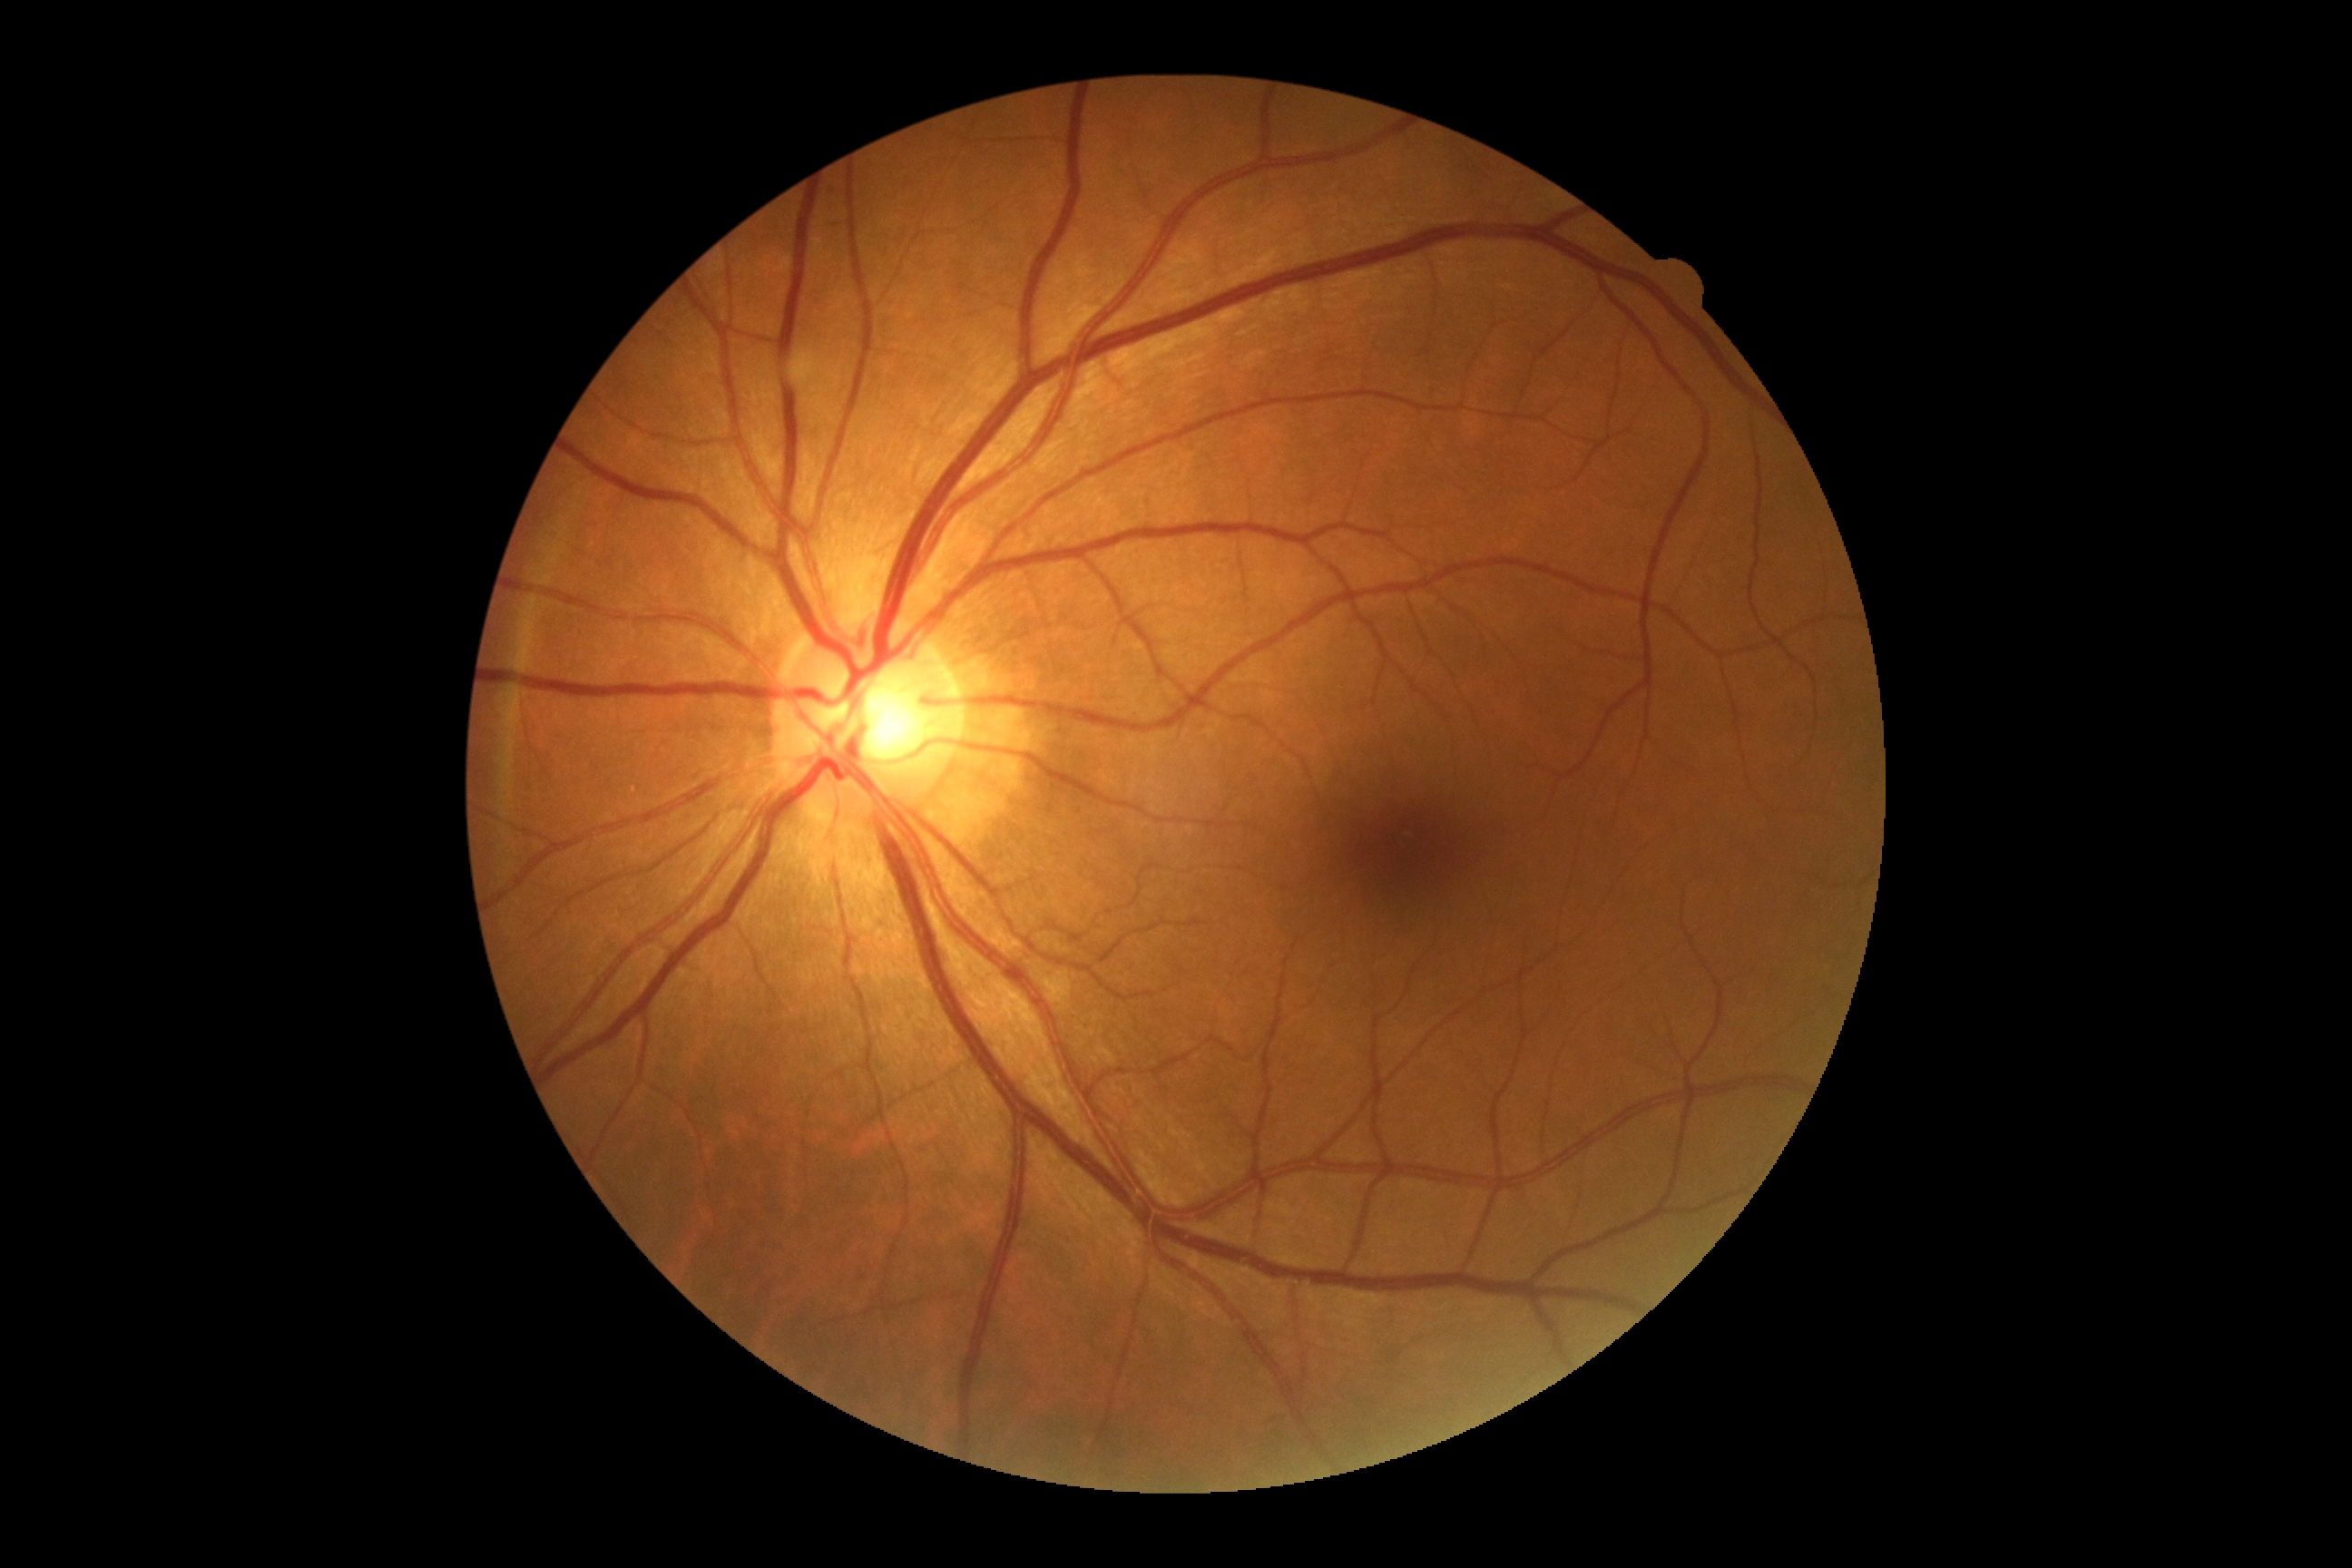

DR impression=no apparent DR; diabetic retinopathy (DR)=0.